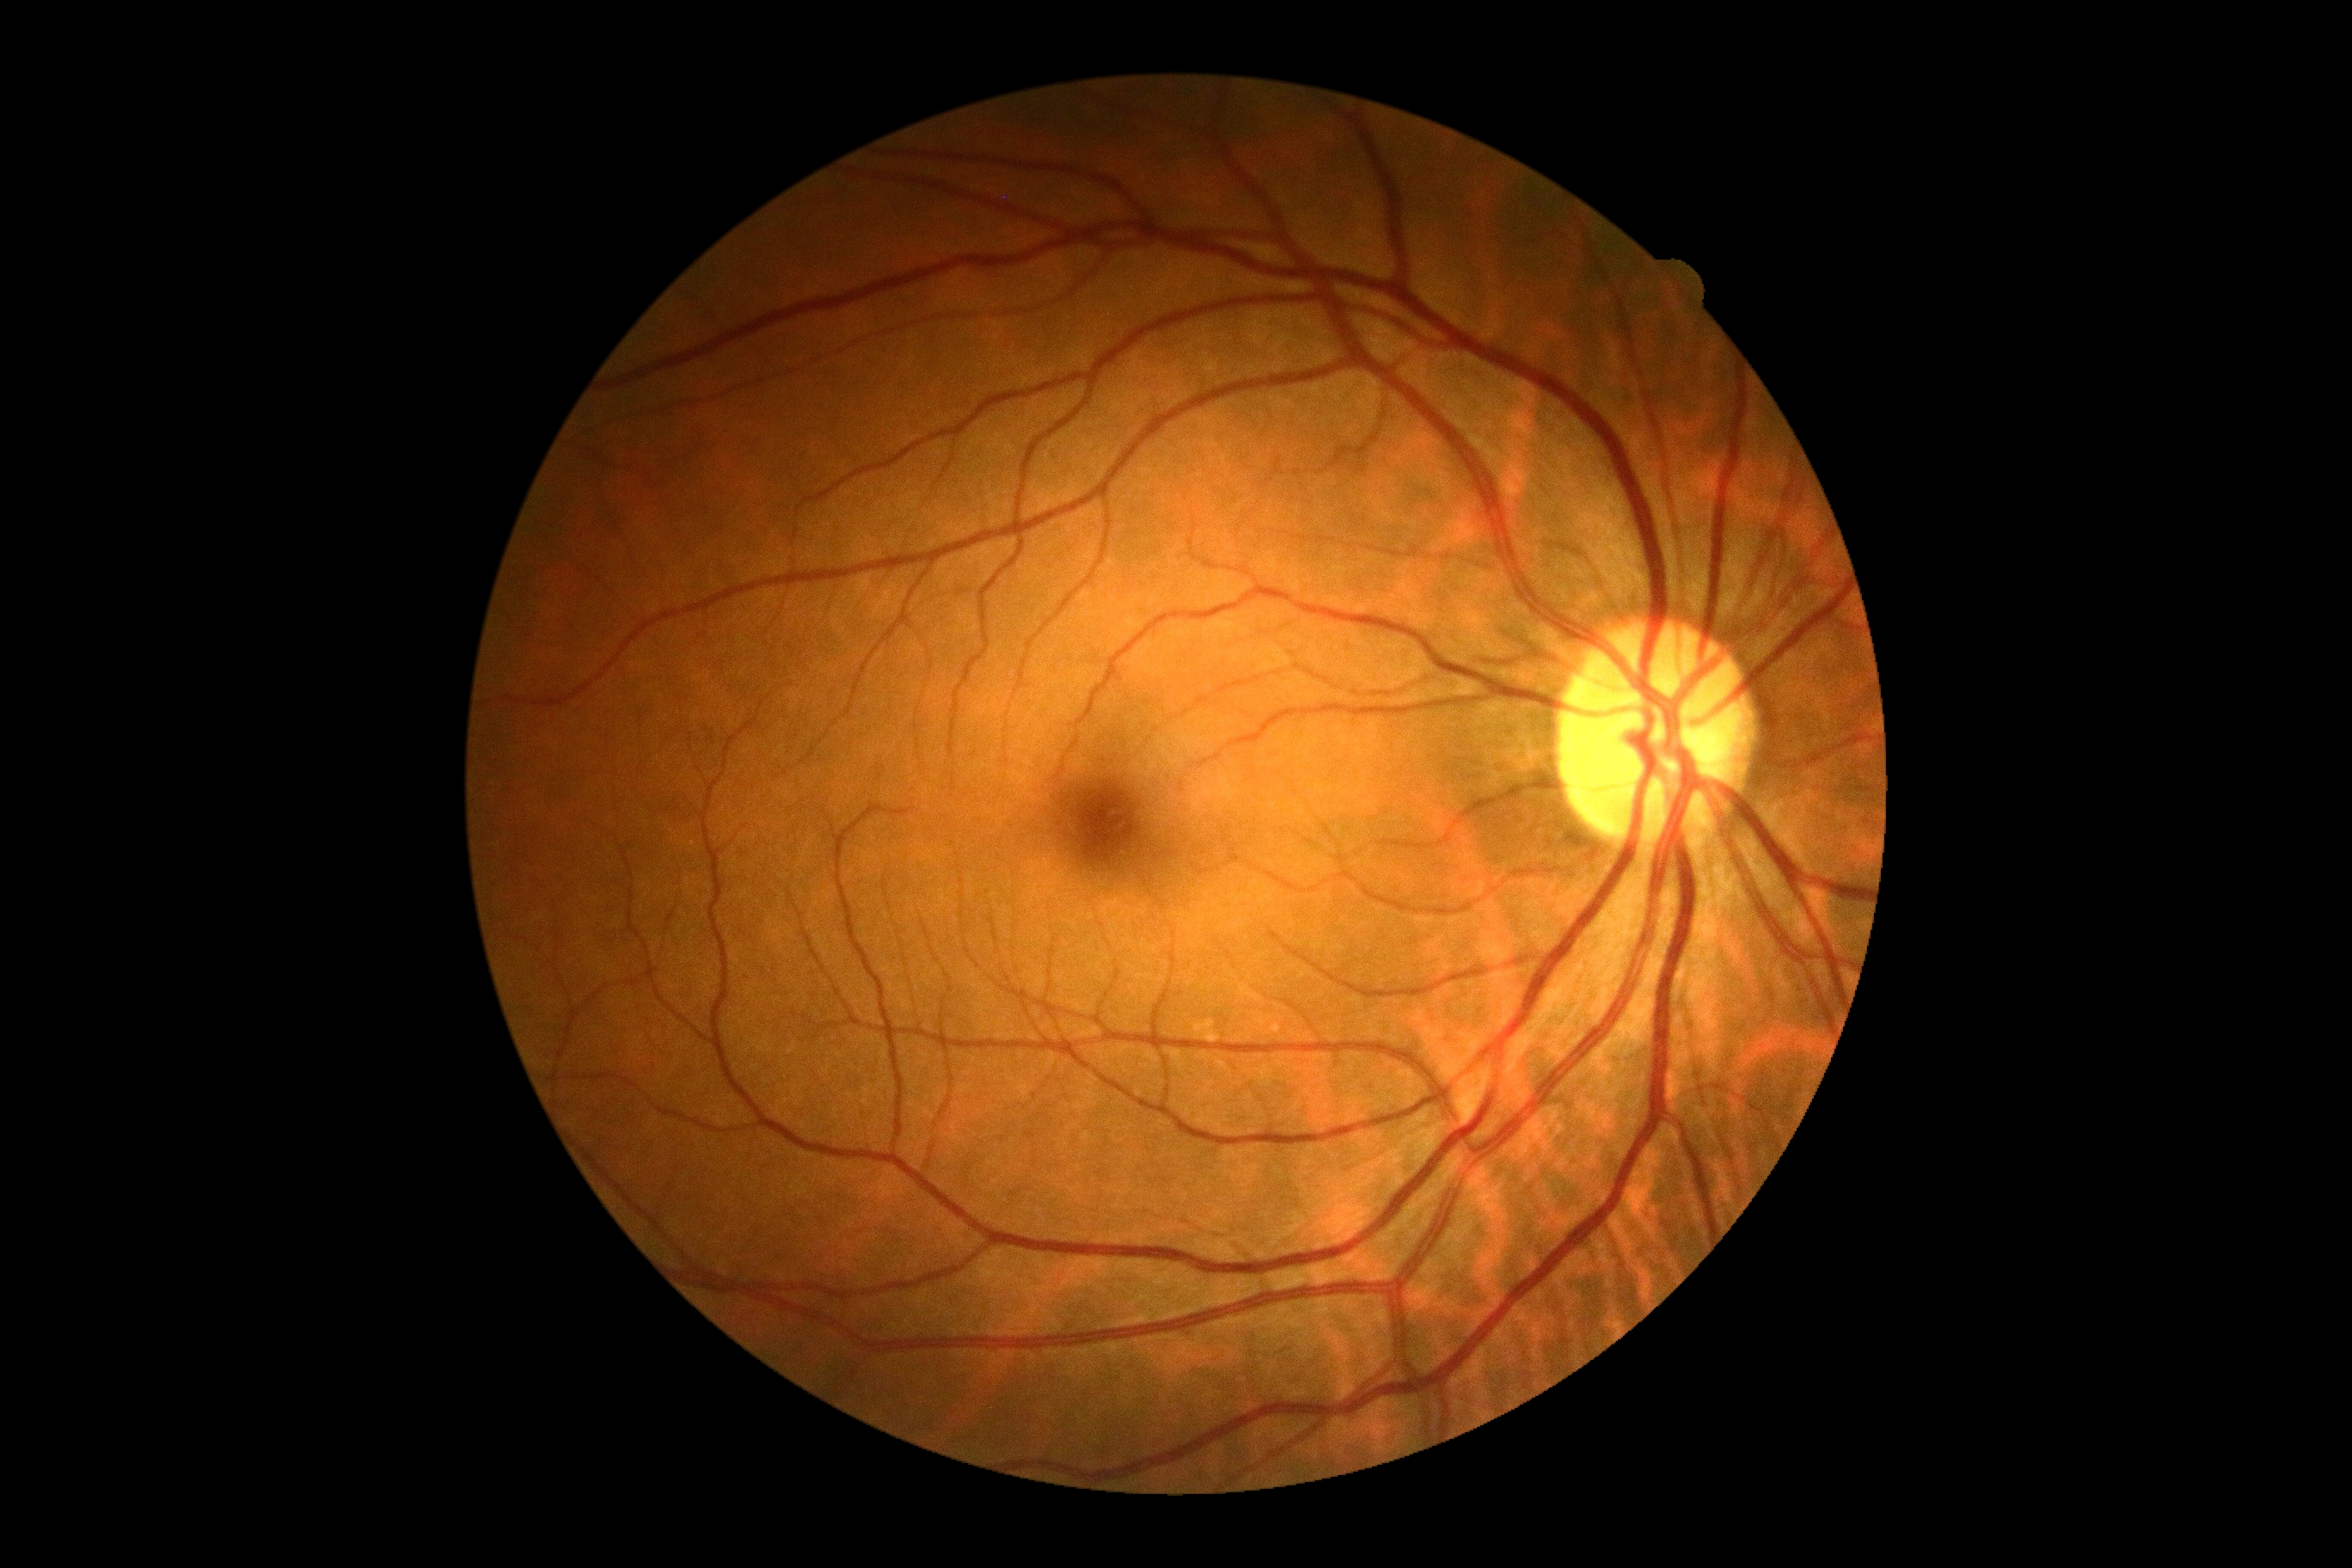
dr_grade: 0/4